Pediatric retinal photograph (wide-field); image size 1240x1240
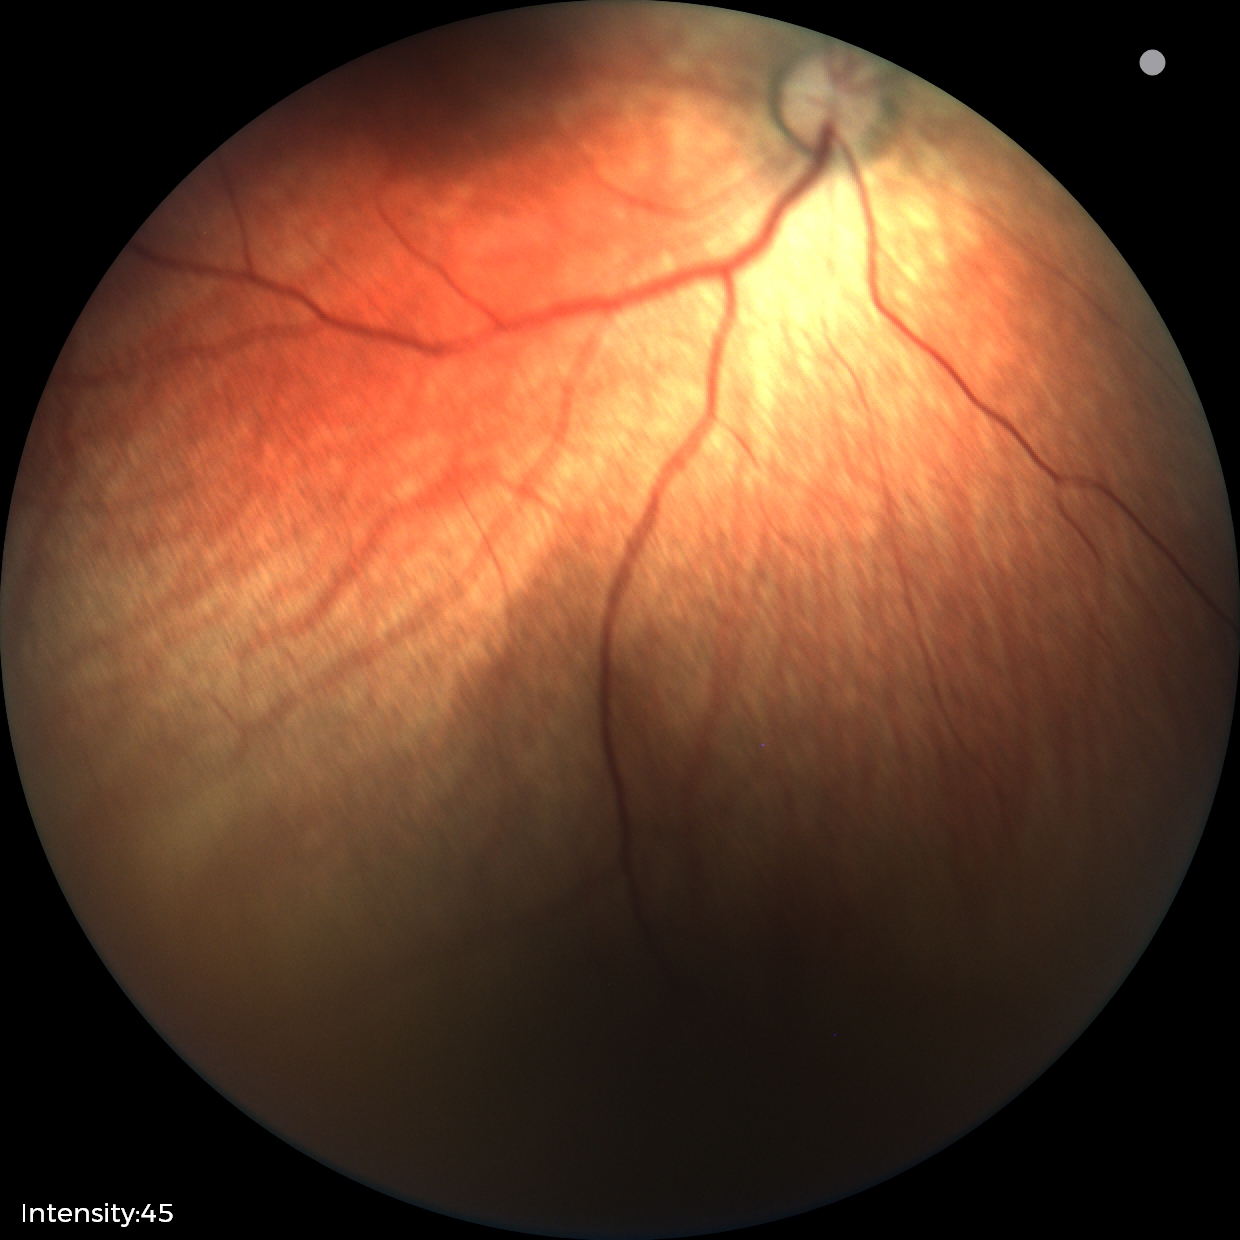
Screening diagnosis: normal retinal appearance.